No pharmacologic dilation · 45° field of view:
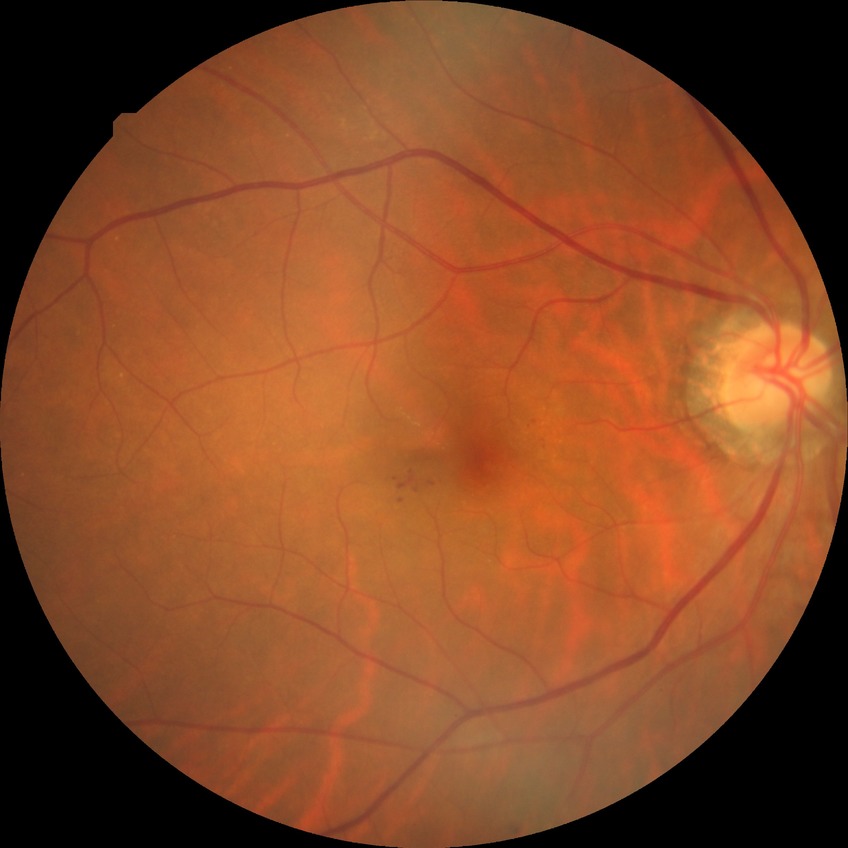
{"davis_grade": "pre-proliferative diabetic retinopathy"}